2100 x 1592 pixels: 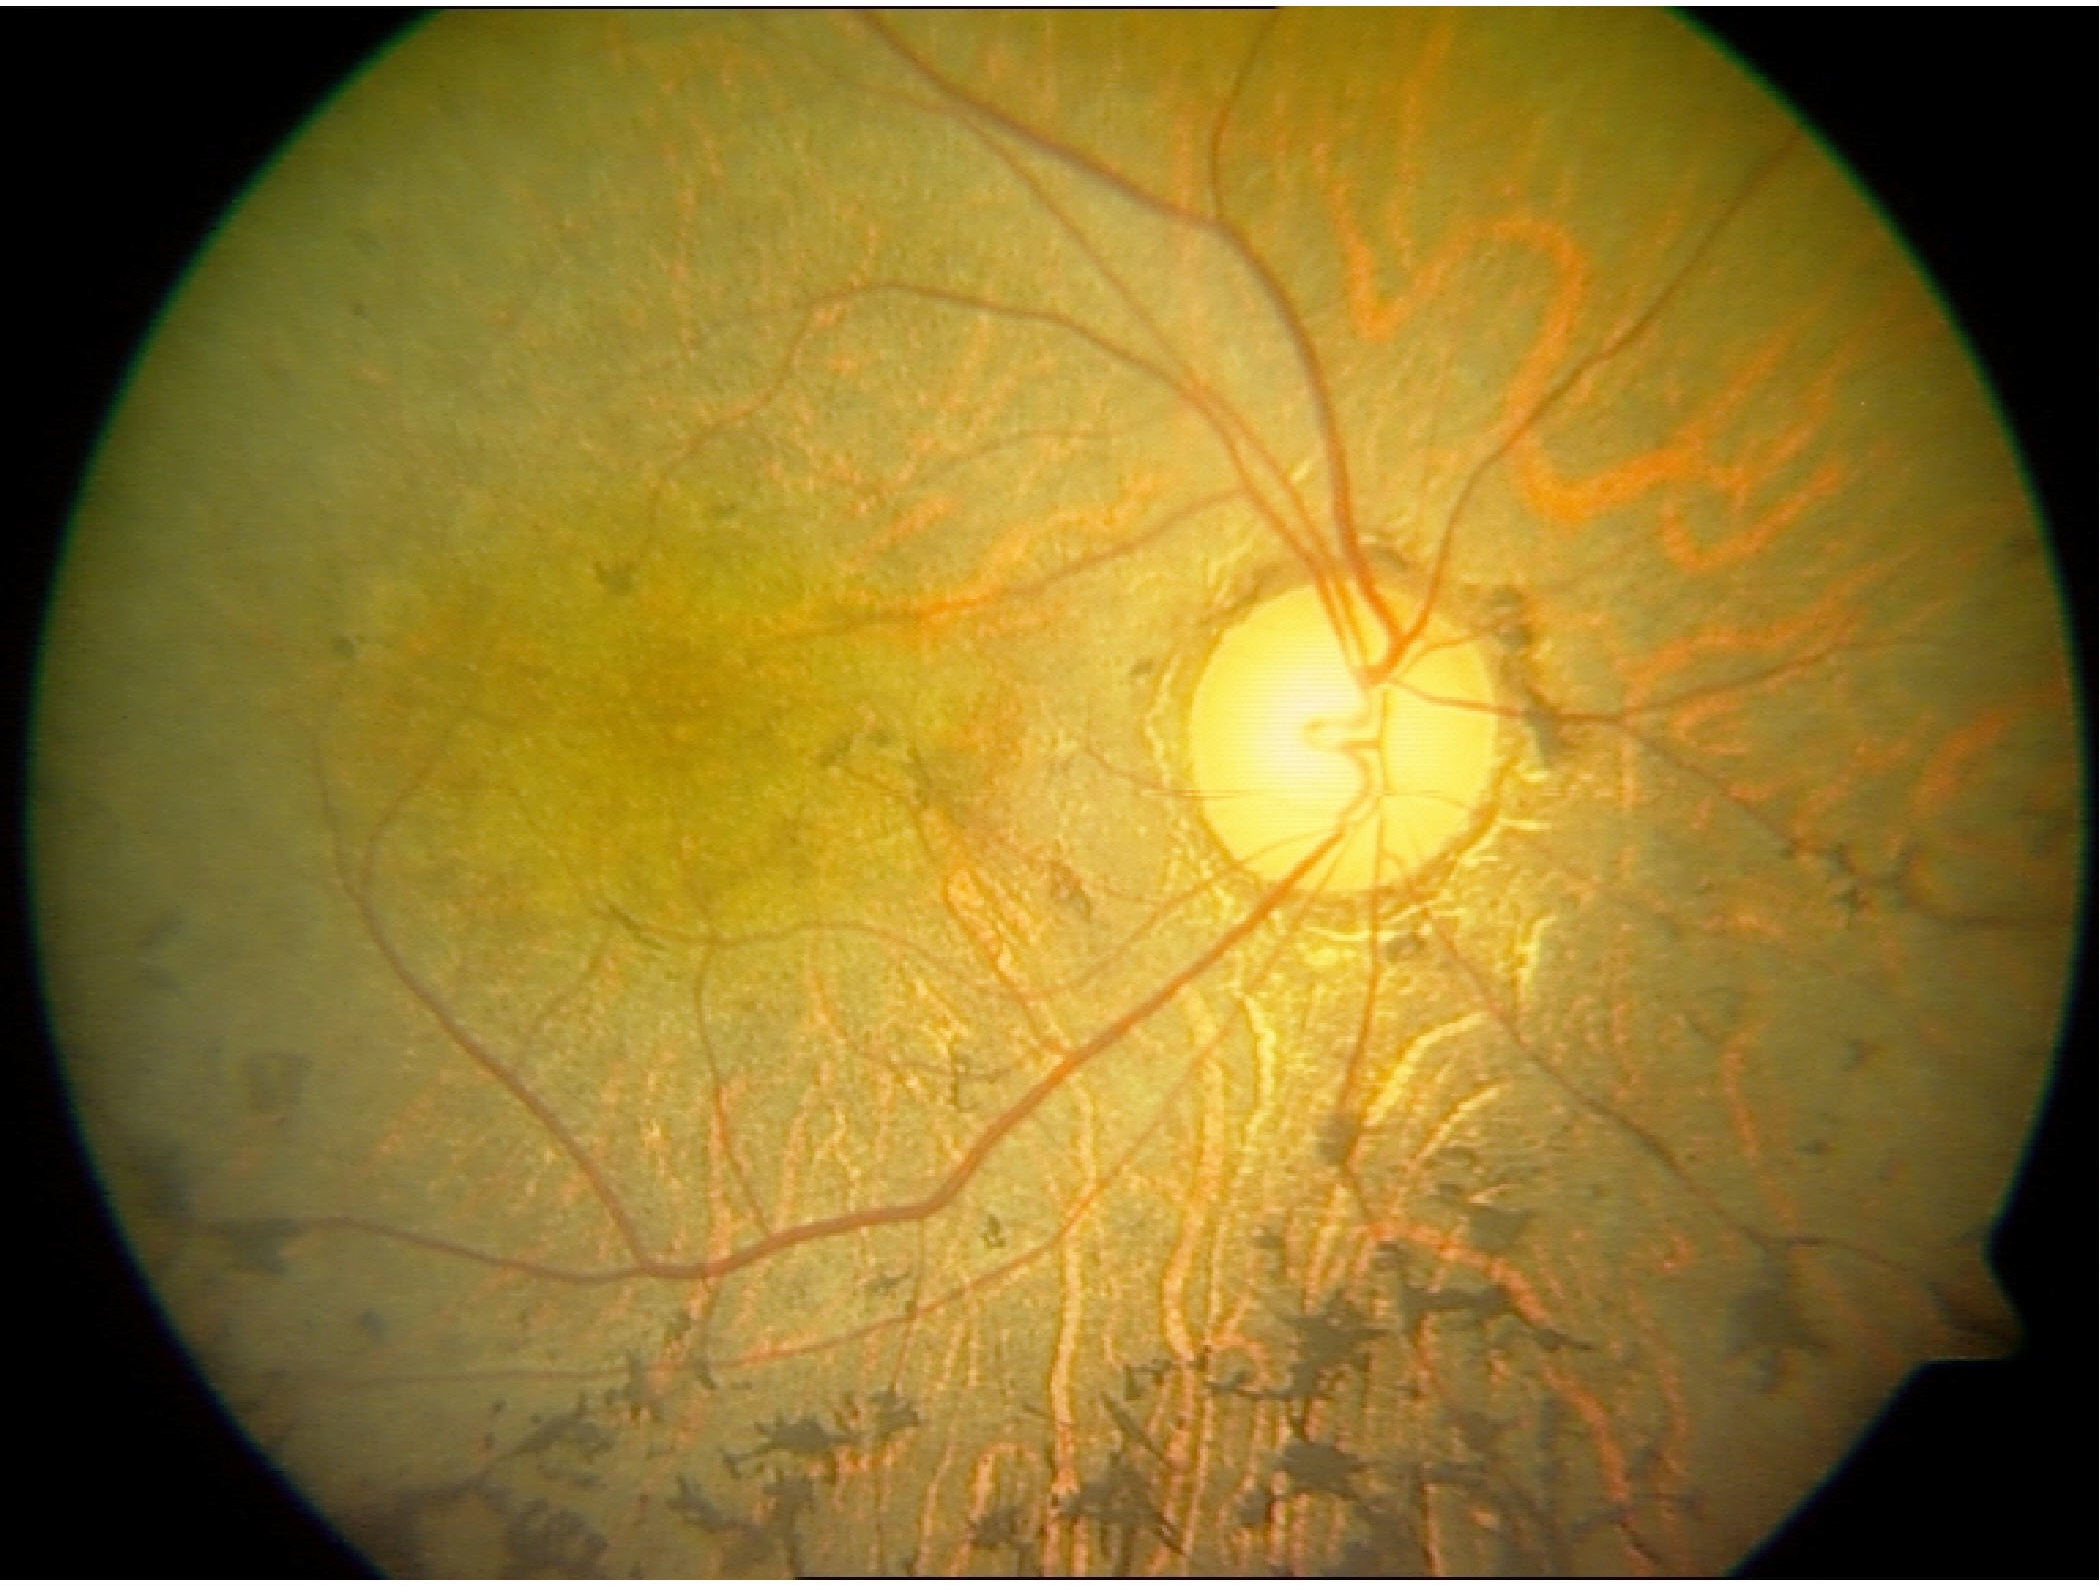

Findings consistent with retinitis pigmentosa.